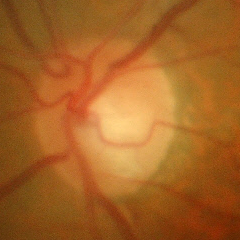
Q: Glaucoma assessment?
A: Yes — early glaucomatous changes. (Criteria: glaucomatous retinal nerve fiber layer defects on red-free fundus photography without visual field defects.)